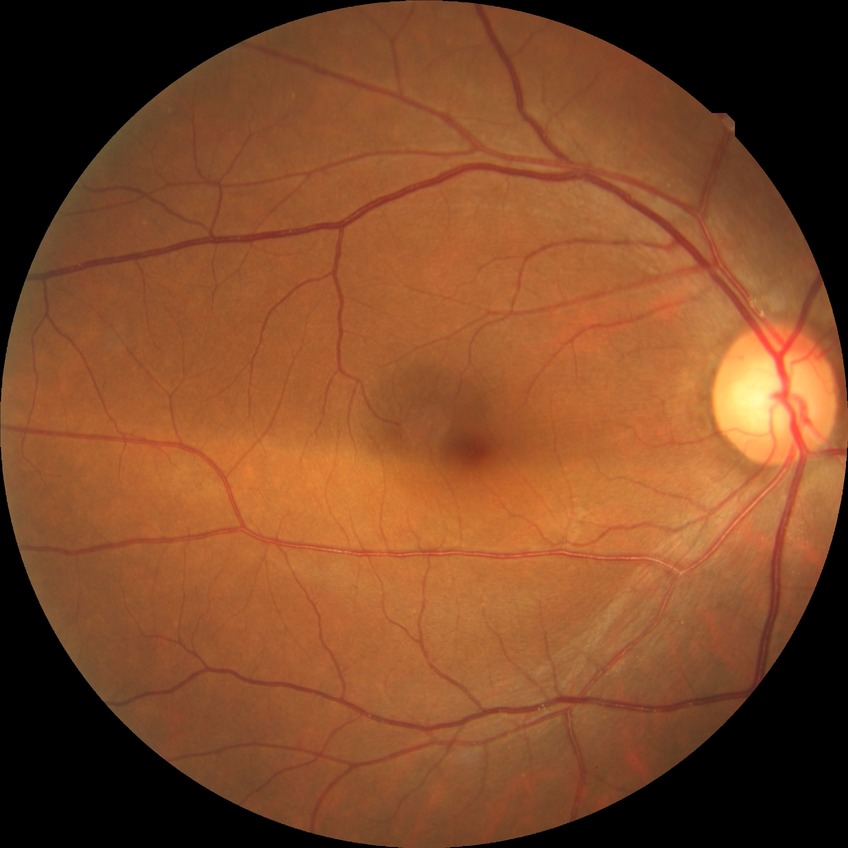
Diabetic retinopathy grade is no diabetic retinopathy.